No pharmacologic dilation, NIDEK AFC-230:
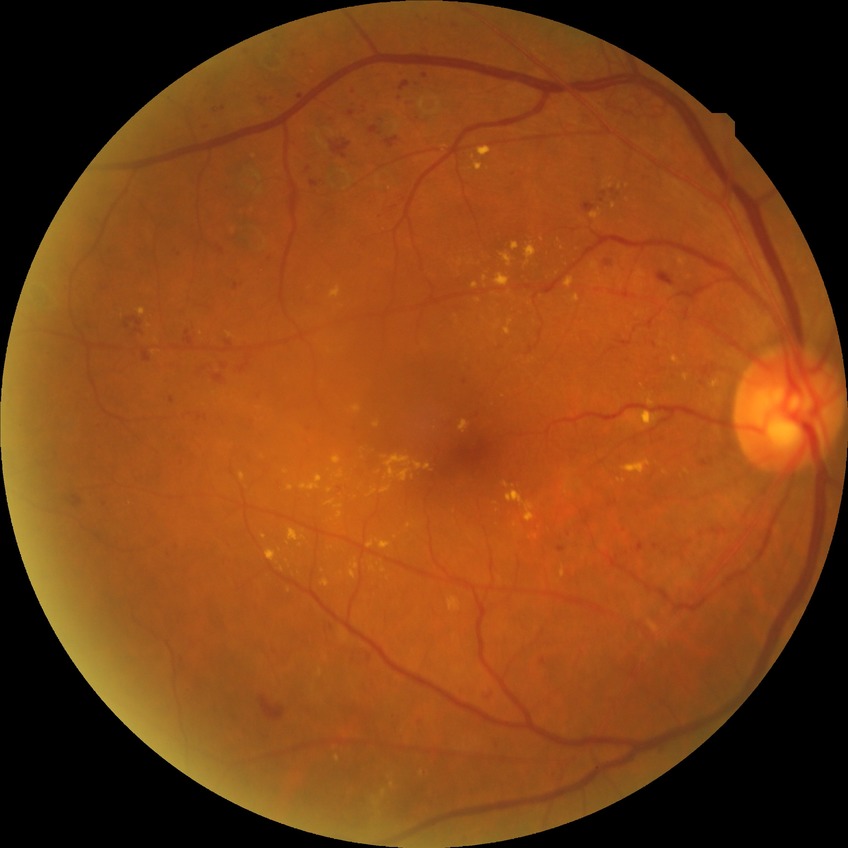 Retinopathy grade is proliferative diabetic retinopathy.